Fundus photo
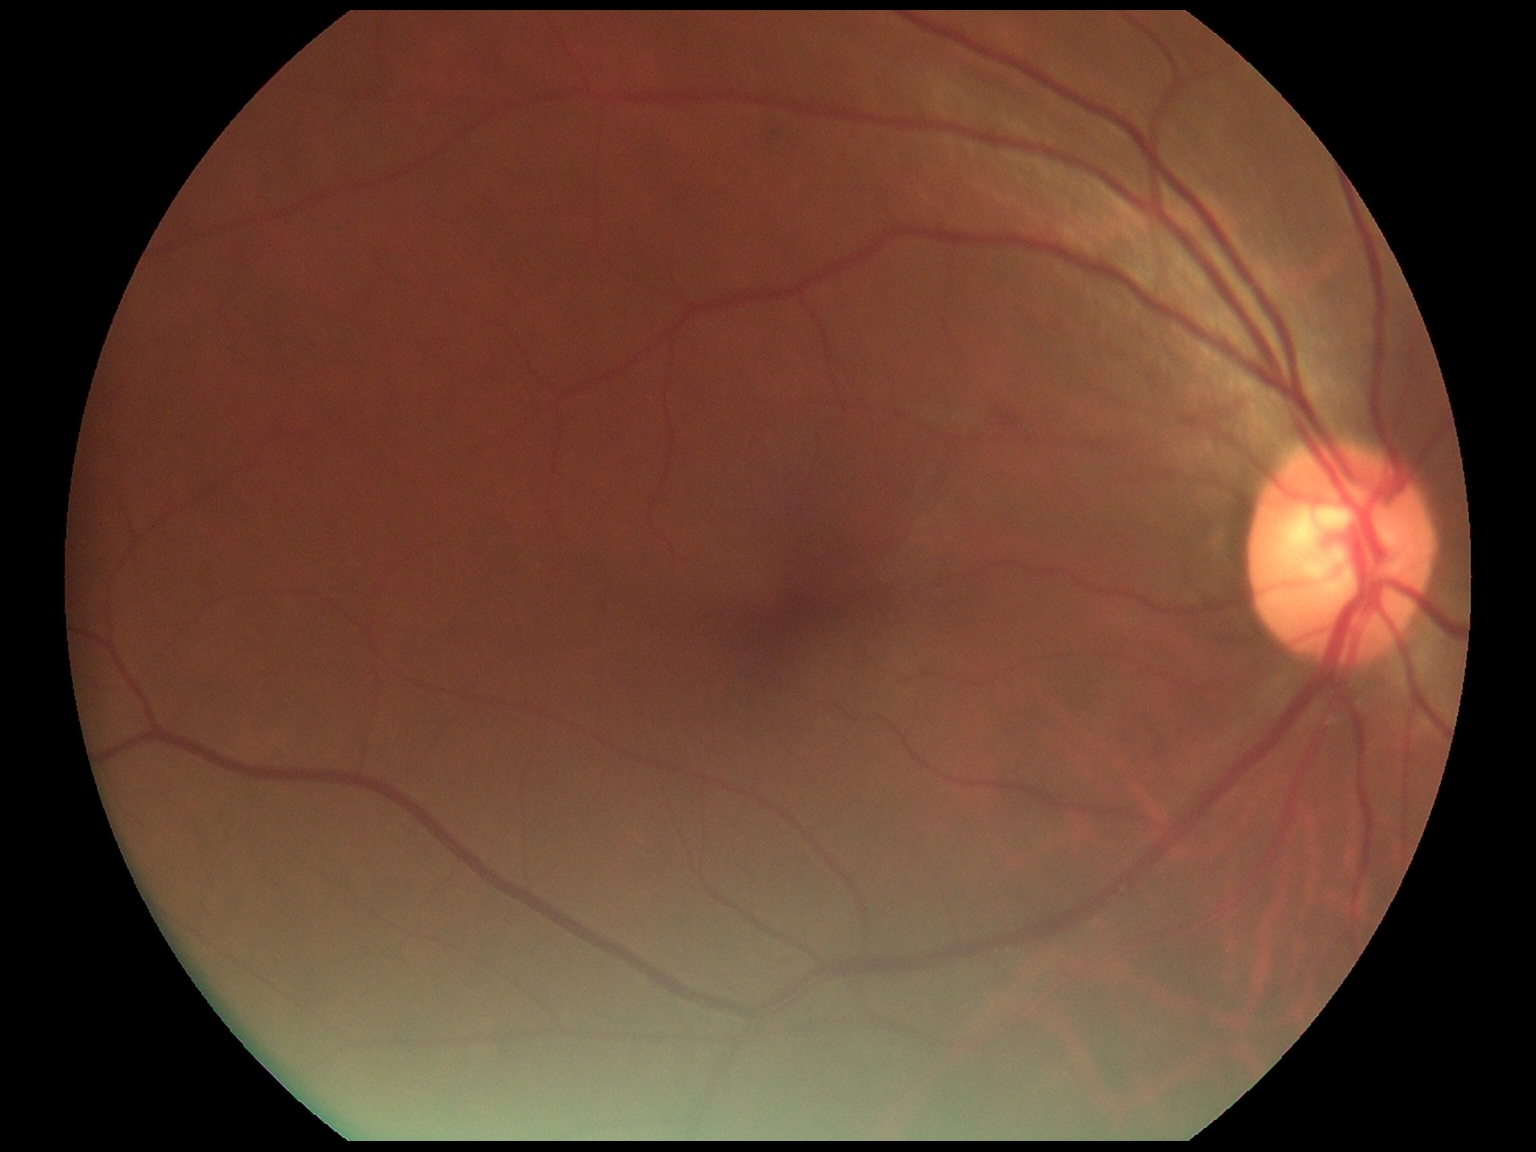
Retinopathy: 0.